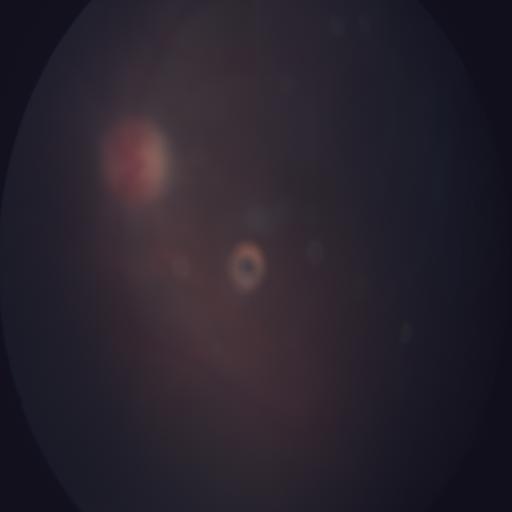
Diagnosis: branch retinal vein occlusion (BRVO).